Modified Davis grading: 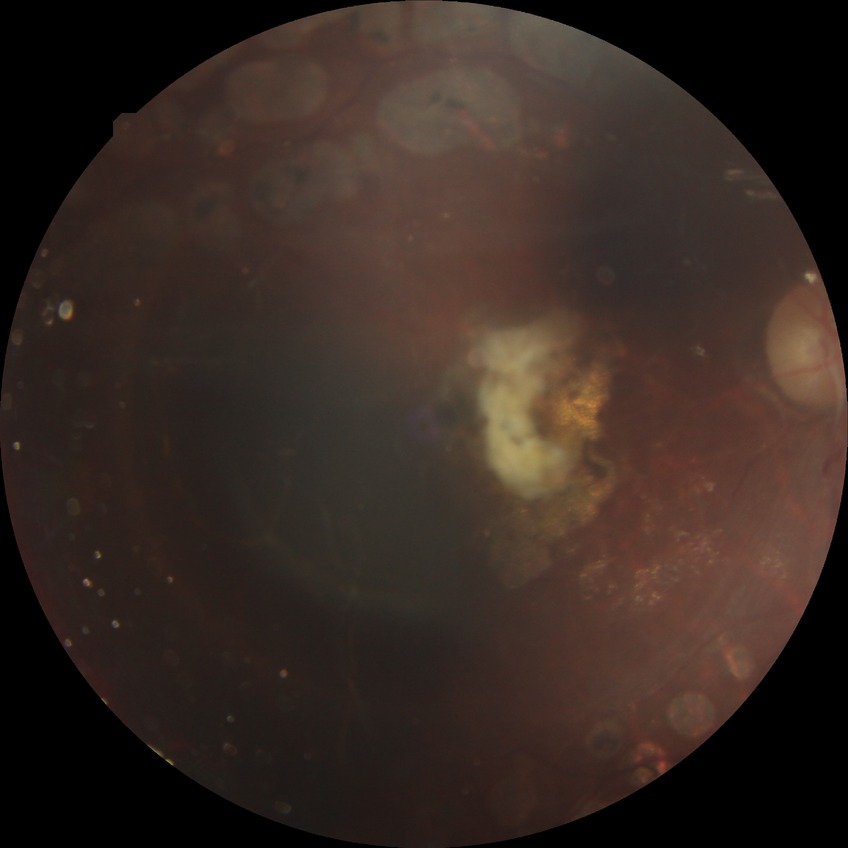
Davis grading is proliferative diabetic retinopathy.